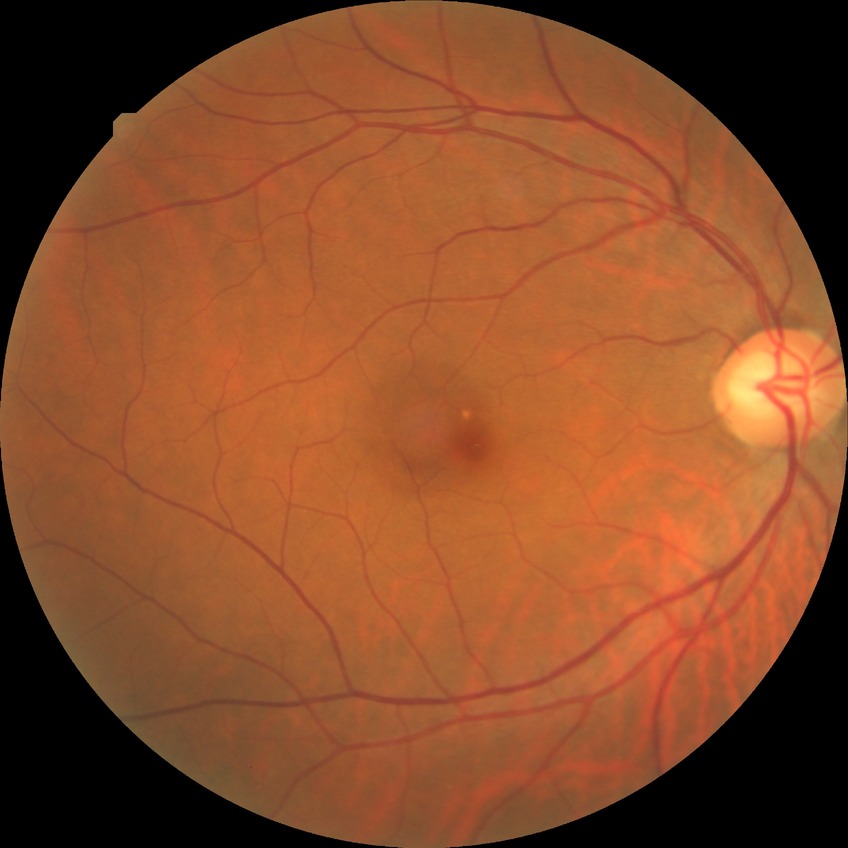

Assessment:
– DR — NDR